Acquired with a NIDEK AFC-230
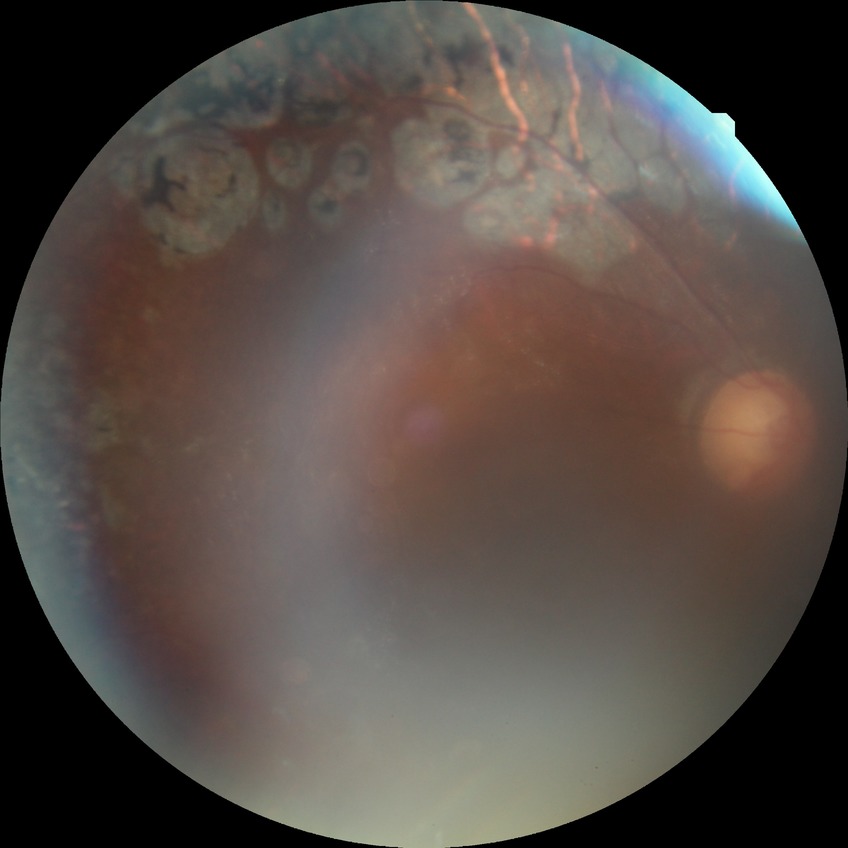

Davis grading: proliferative diabetic retinopathy.